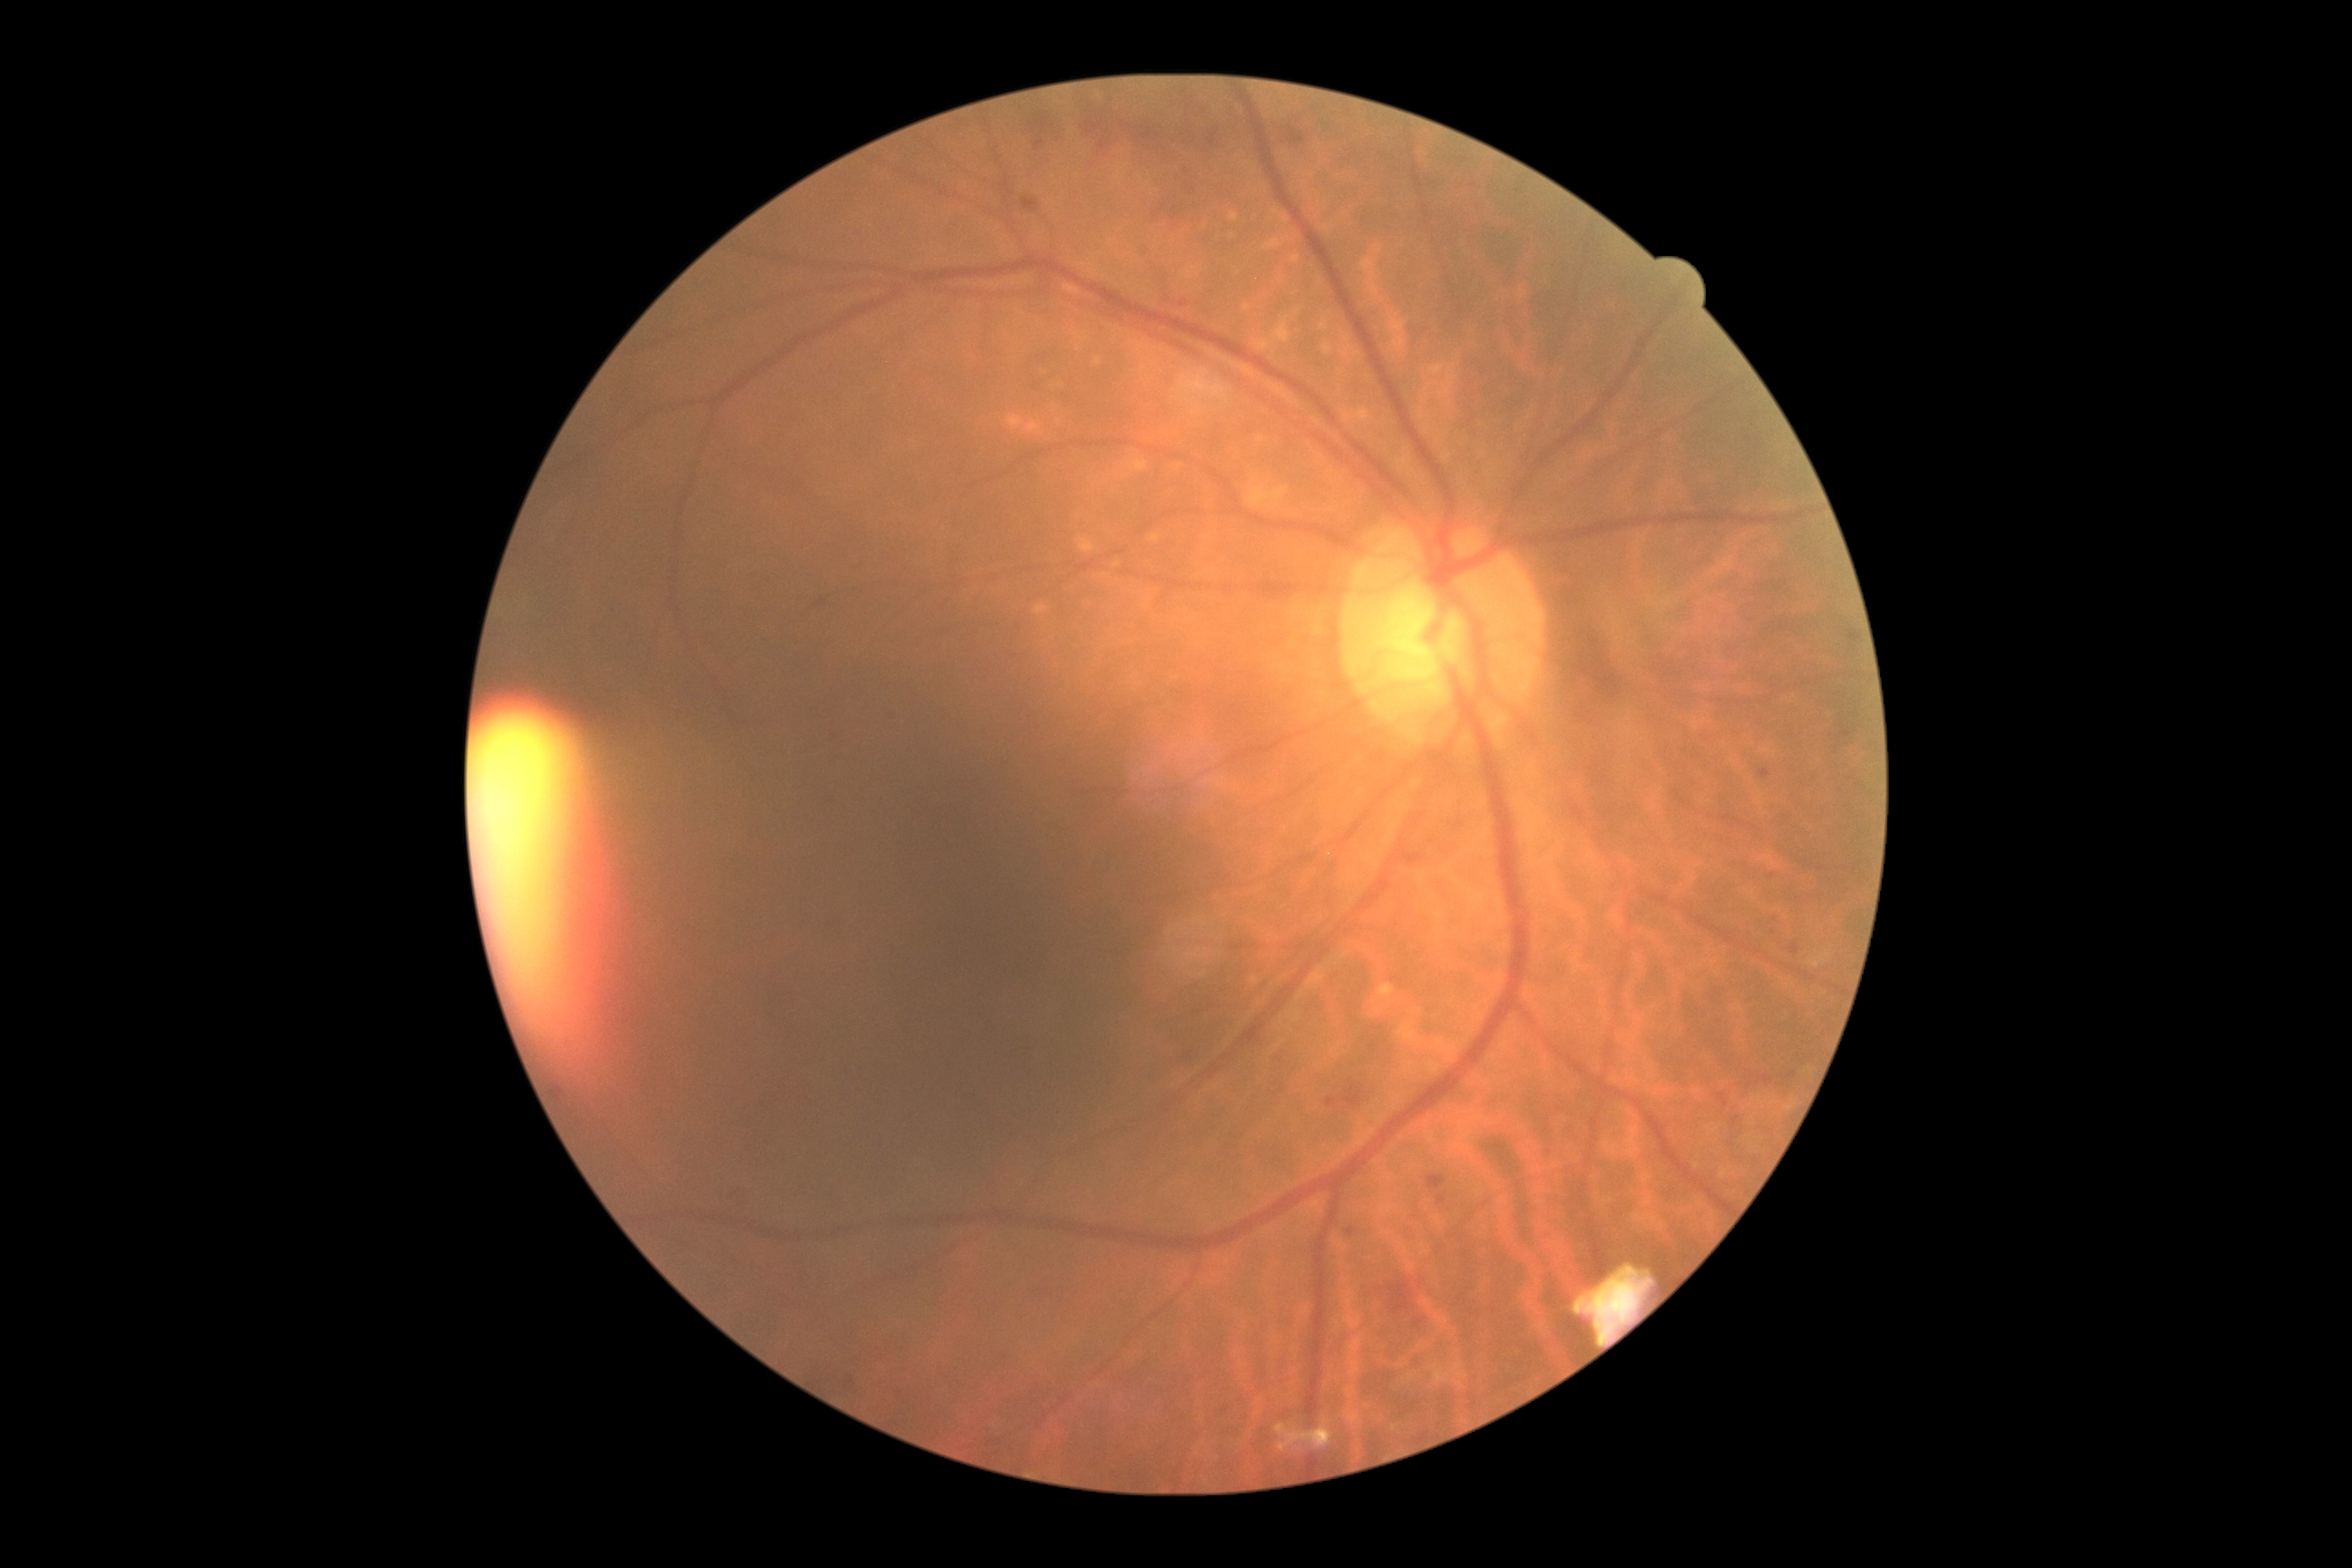 Annotations:
- DR class — non-proliferative diabetic retinopathy
- diabetic retinopathy — grade 2 (moderate NPDR)